DR severity per modified Davis staging.
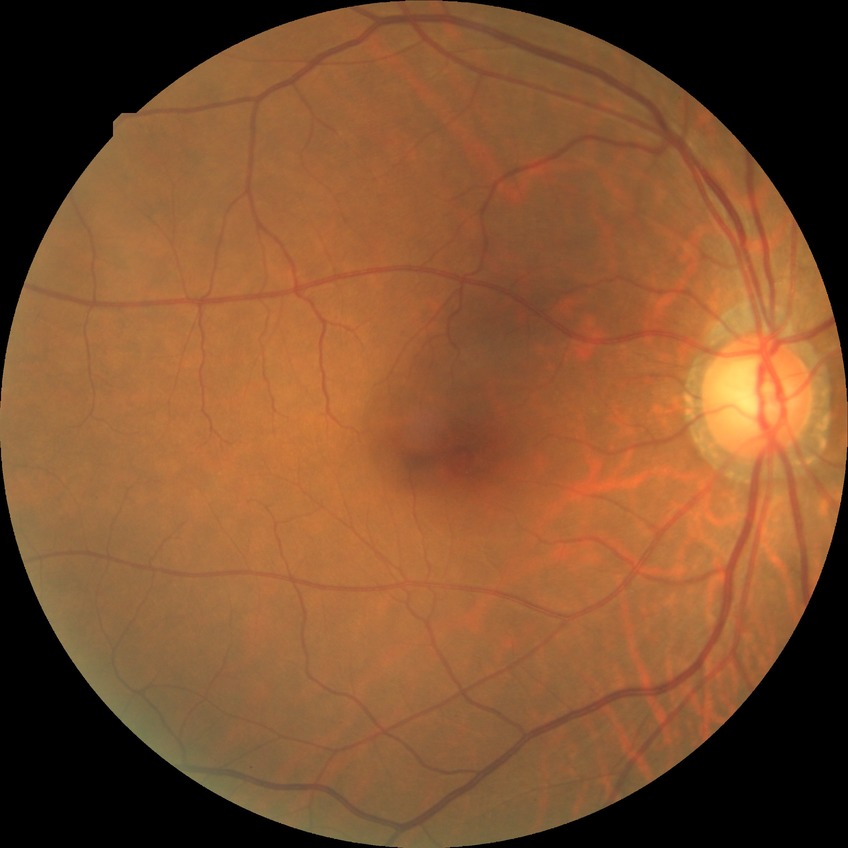
Diabetic retinopathy stage is no diabetic retinopathy.